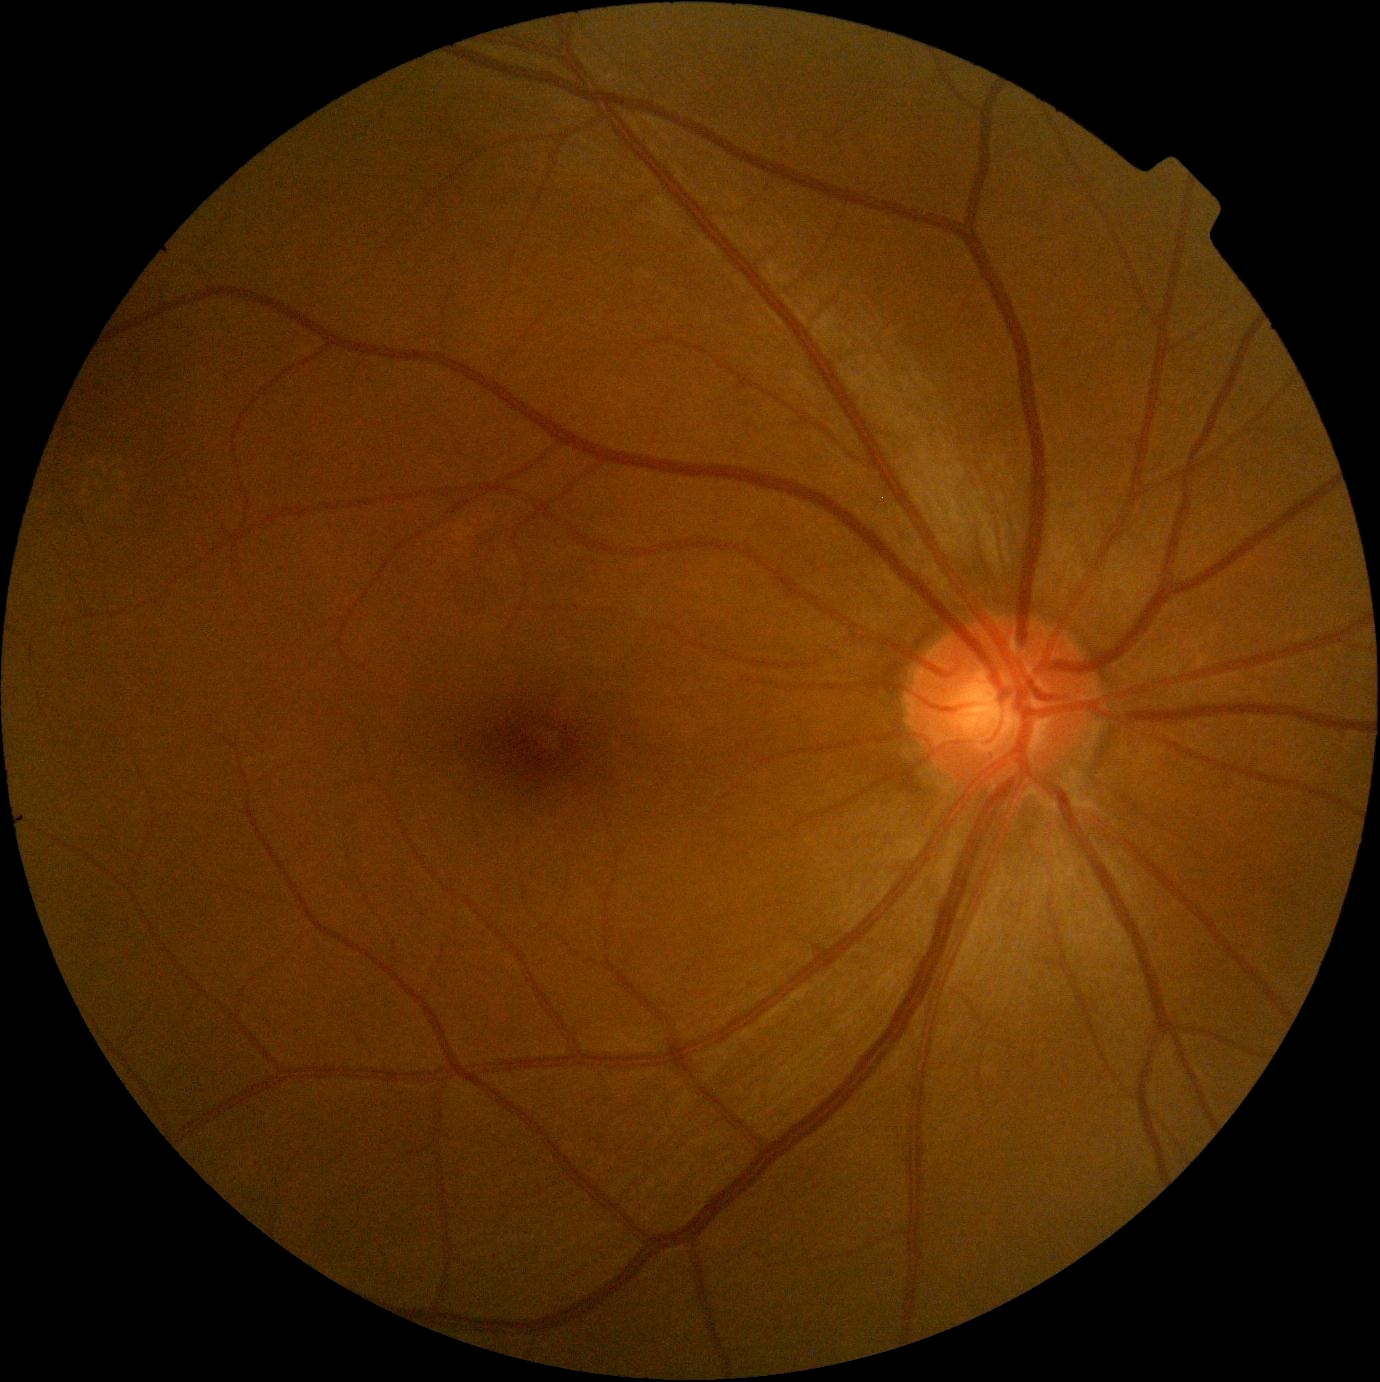
No signs of diabetic retinopathy. Diabetic retinopathy grade is 0/4.